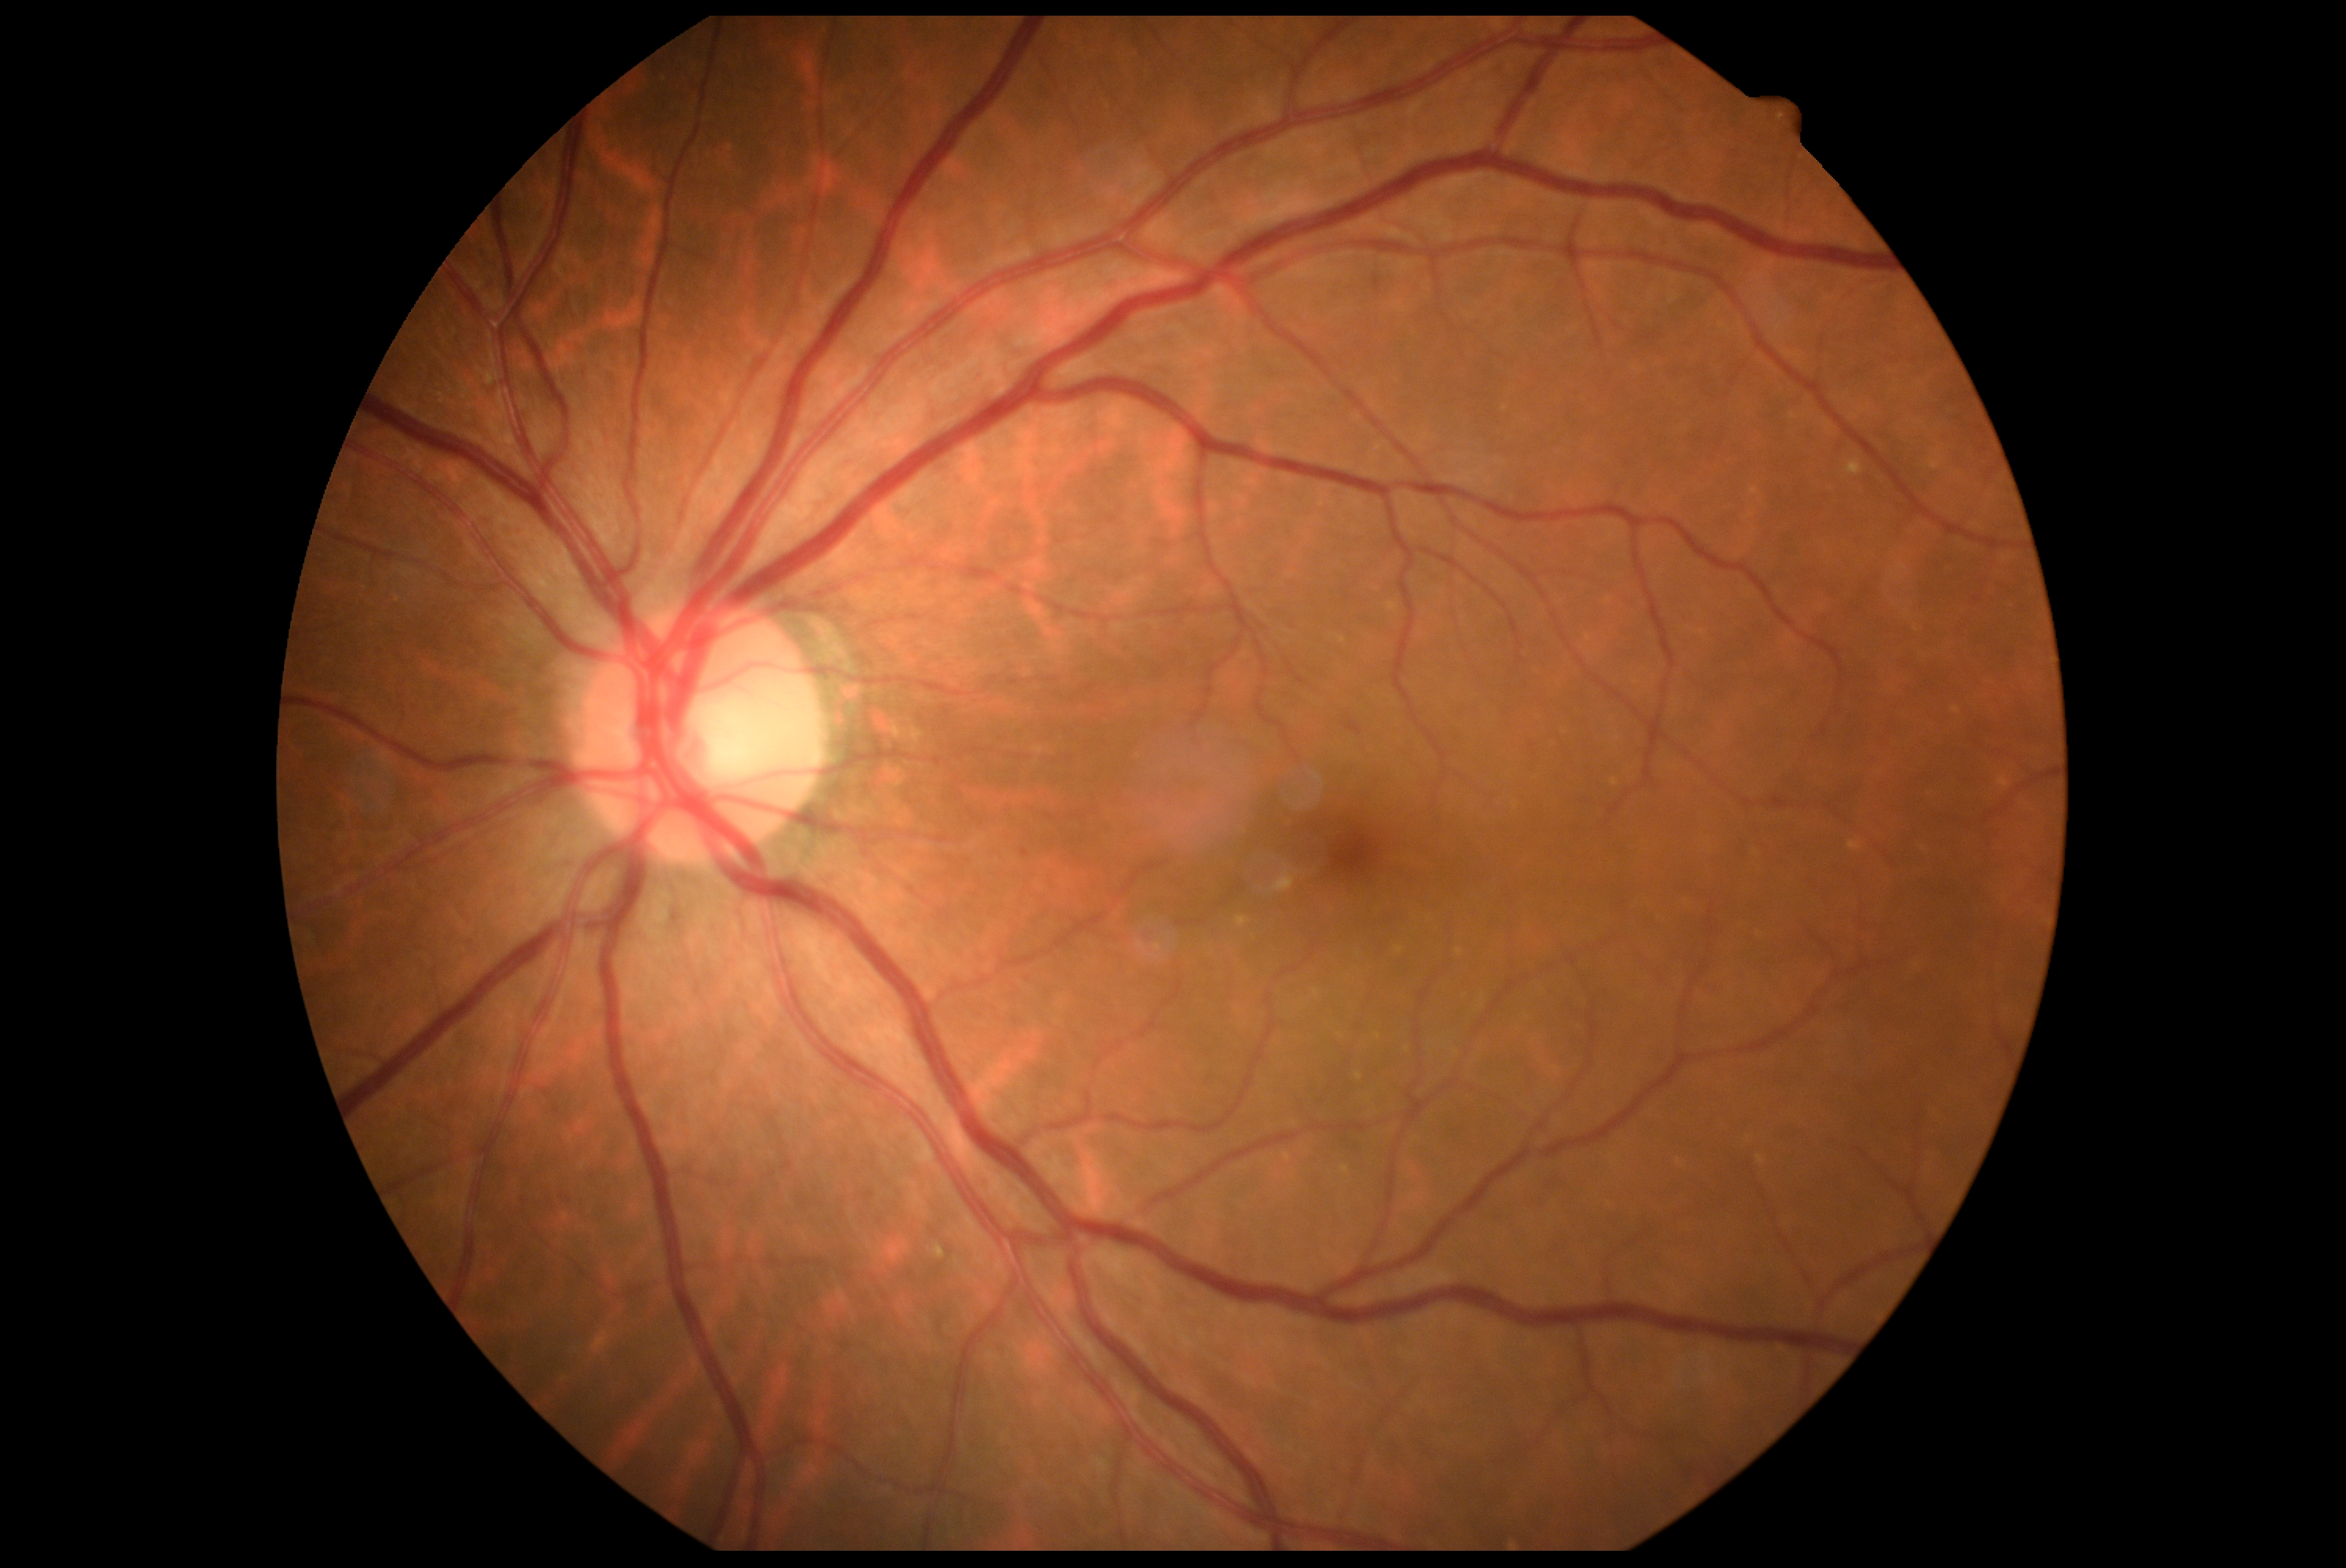

DR grade is no apparent diabetic retinopathy (0).